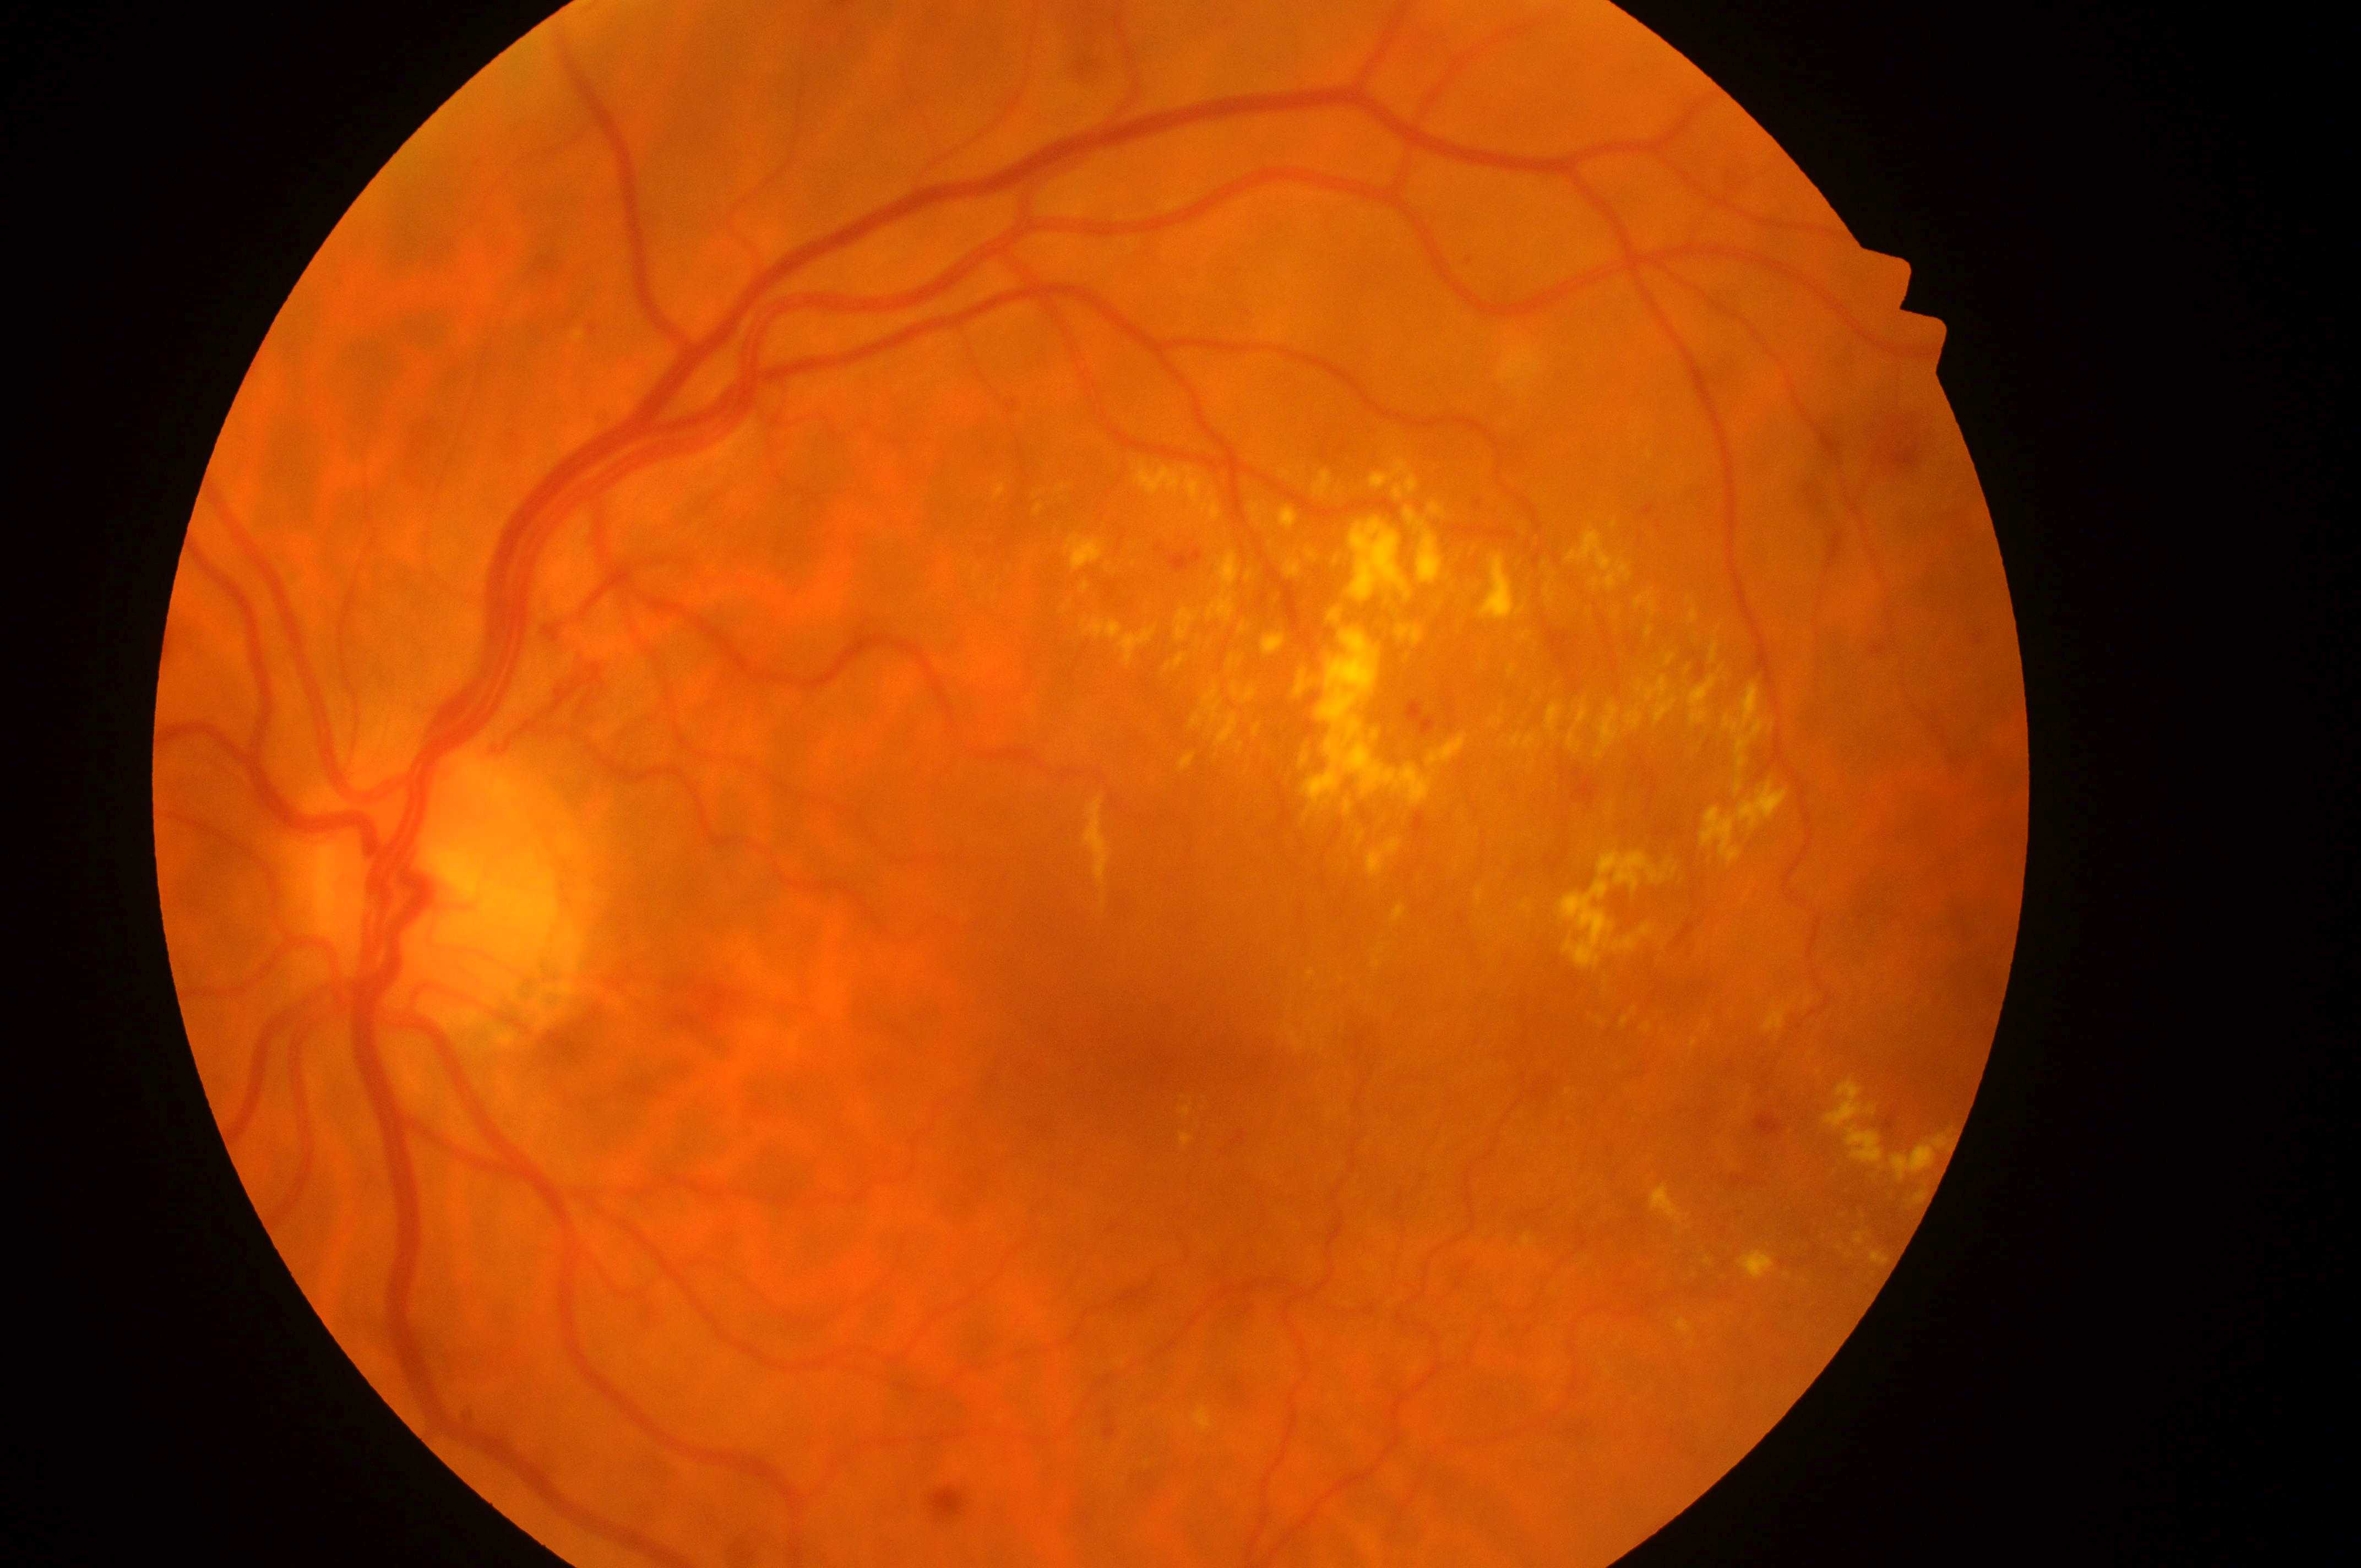 DME: high risk (grade 2). The ONH is at (x=449, y=901). Macular center: (x=1149, y=1055). DR grade is severe NPDR (3). The image shows the left eye.